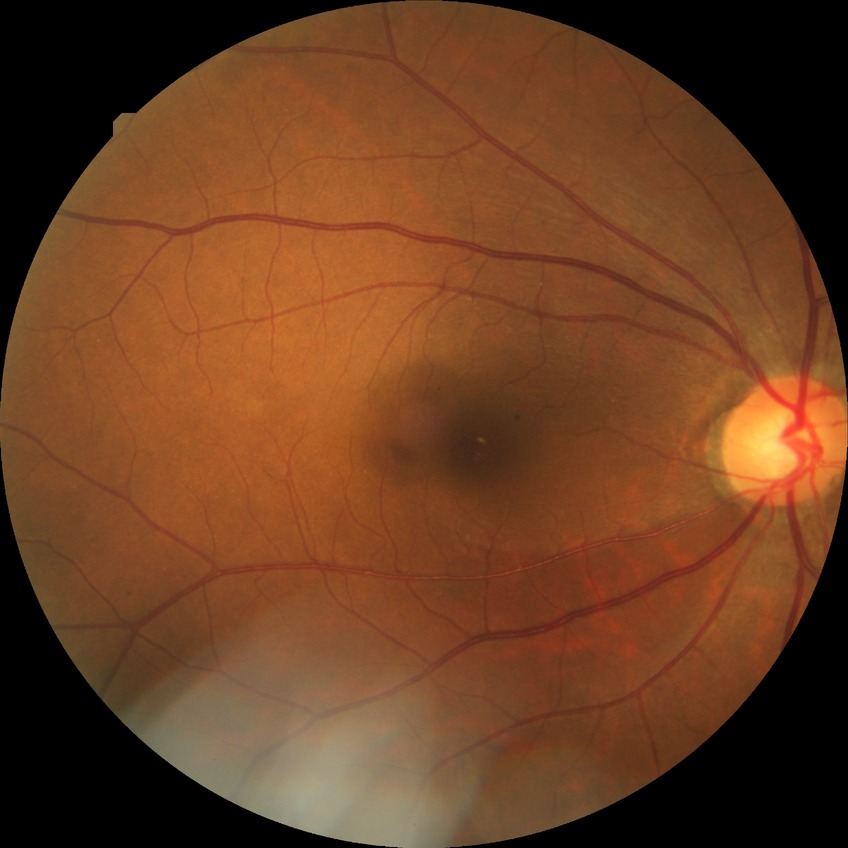
Diabetic retinopathy (DR): SDR (simple diabetic retinopathy).